1240x1240; wide-field fundus image from infant ROP screening — 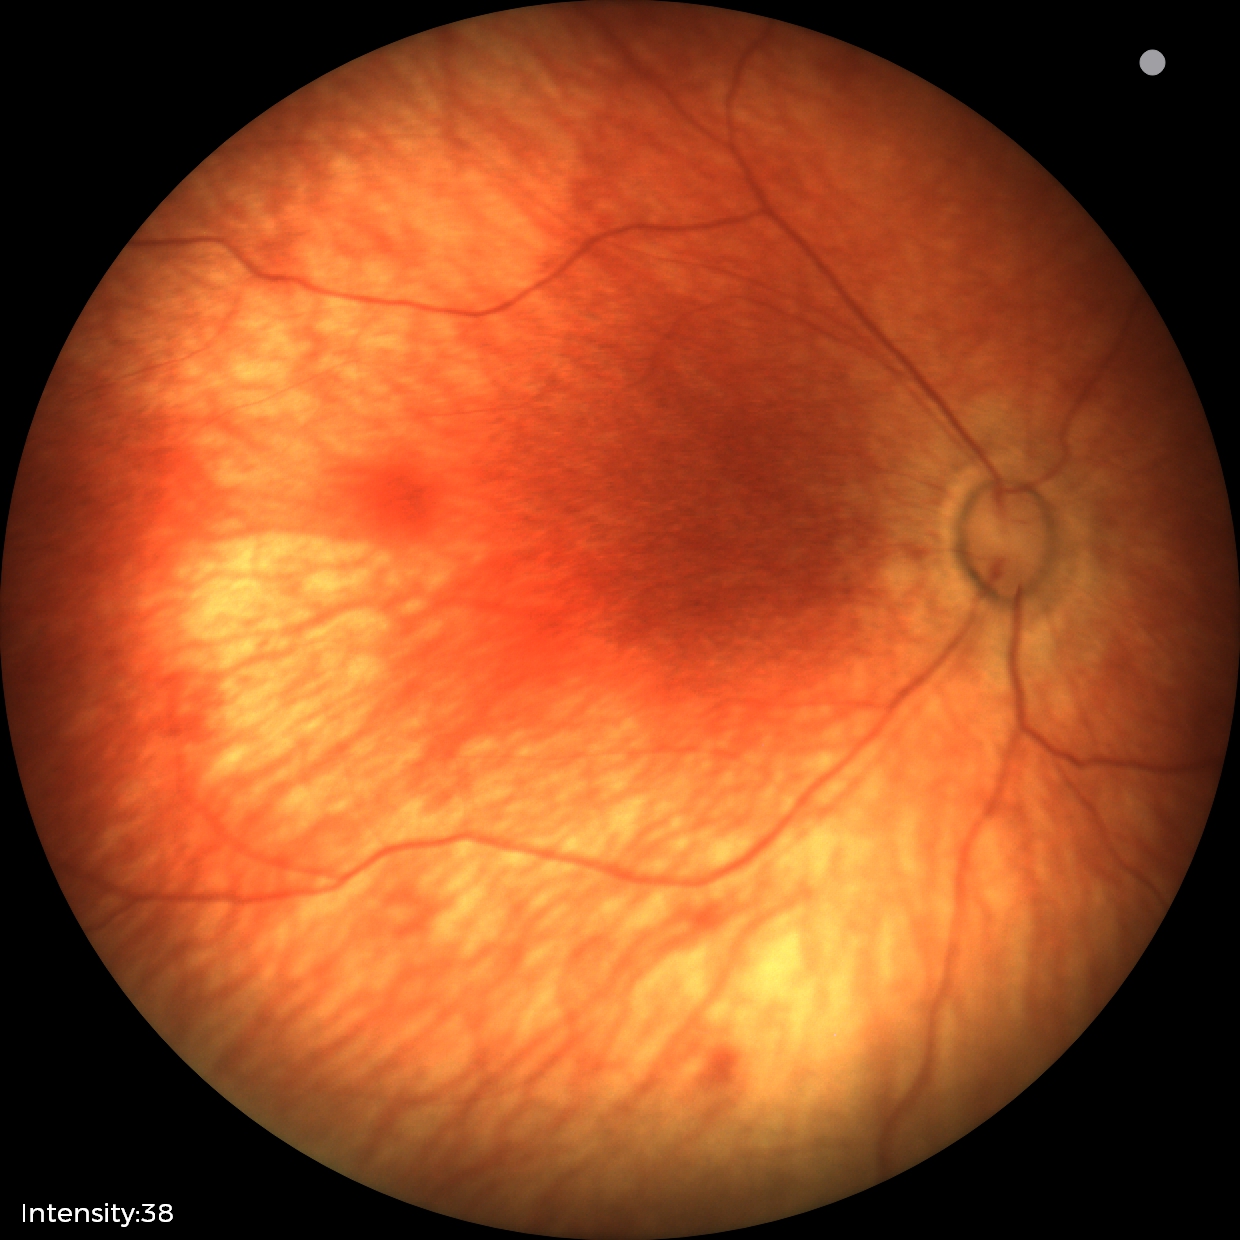

Physiological retinal appearance for postconceptual age.